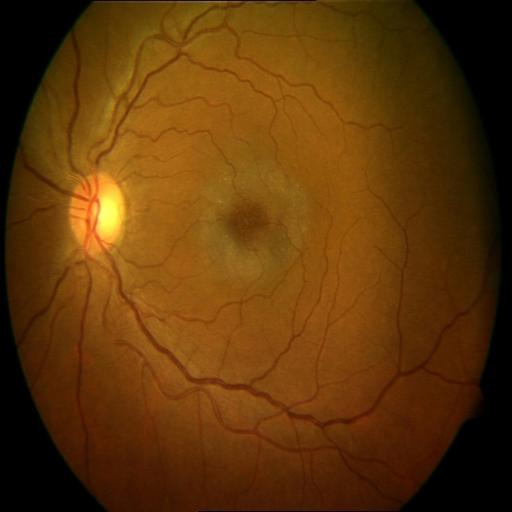
The image shows cystoid macular edema.